Retinal fundus photograph.
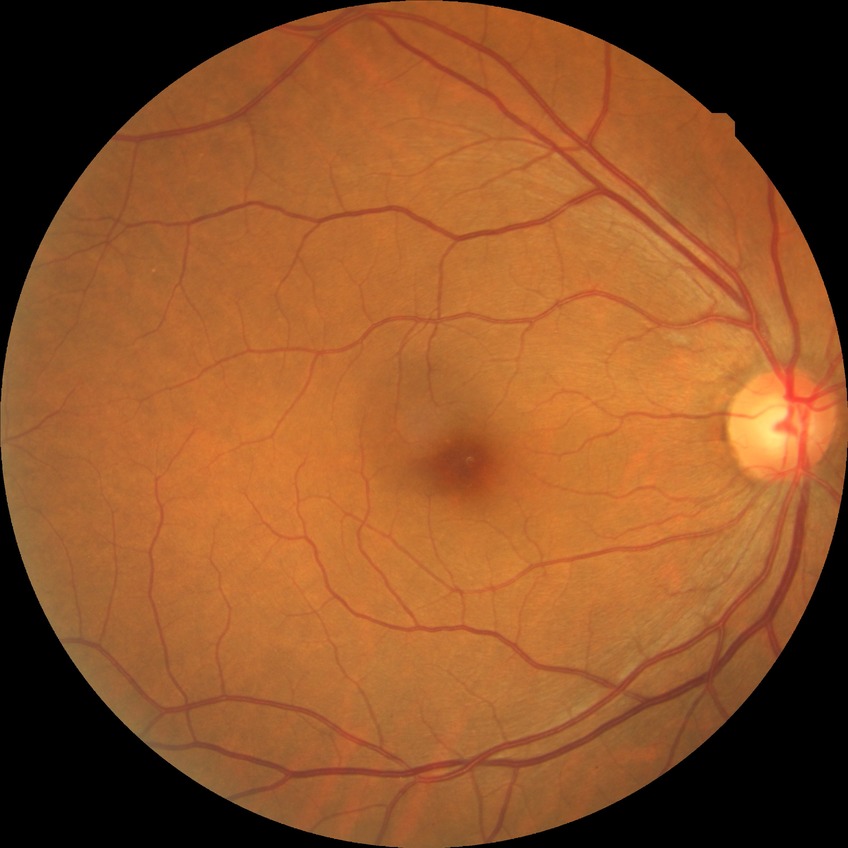

Diabetic retinopathy (DR): no diabetic retinopathy (NDR).